Retinal fundus photograph — 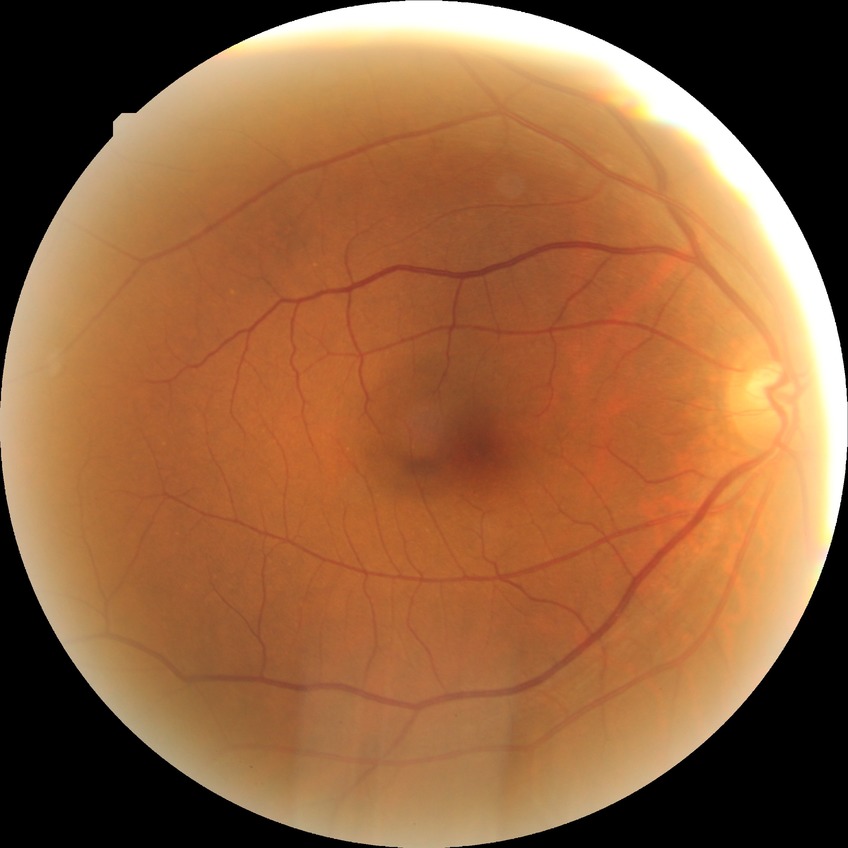

diabetic retinopathy (DR)=no diabetic retinopathy (NDR).